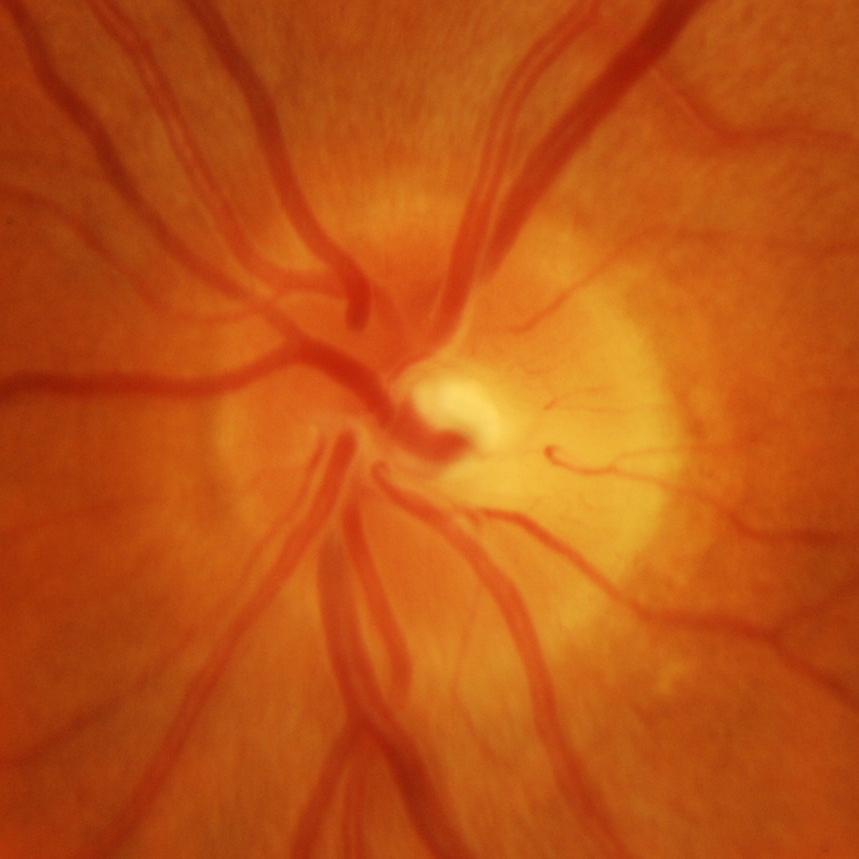

Glaucoma diagnosis: glaucomatous optic neuropathy.